Non-mydriatic acquisition
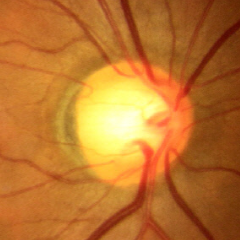 Showing no glaucomatous findings.